Diabetic retinopathy graded by the modified Davis classification:
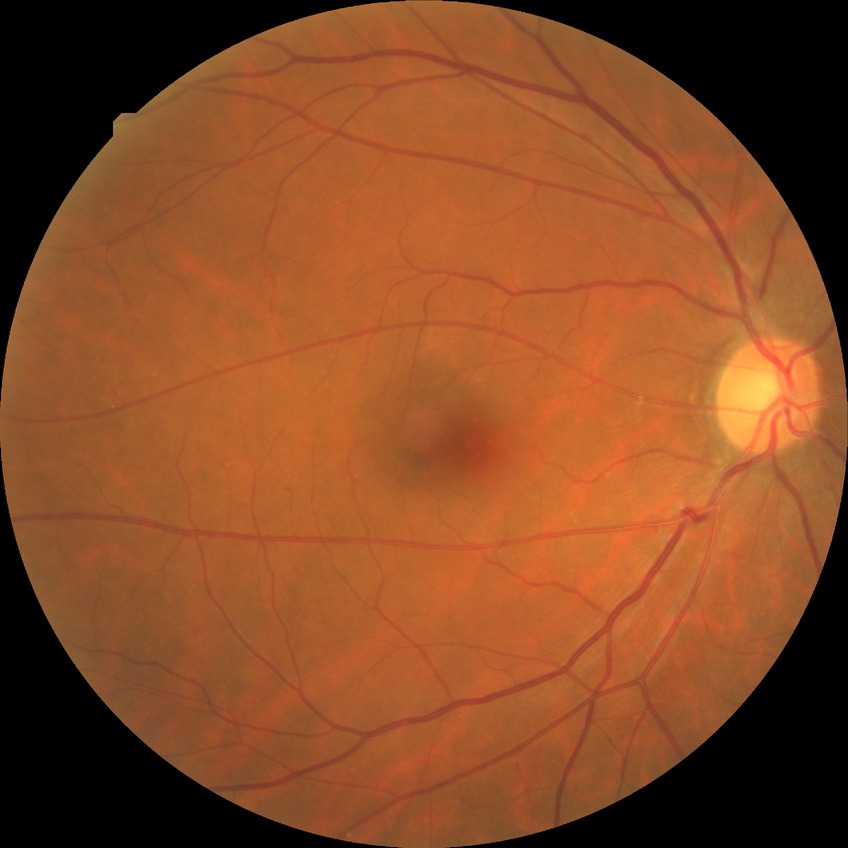

davis_grade: no diabetic retinopathy